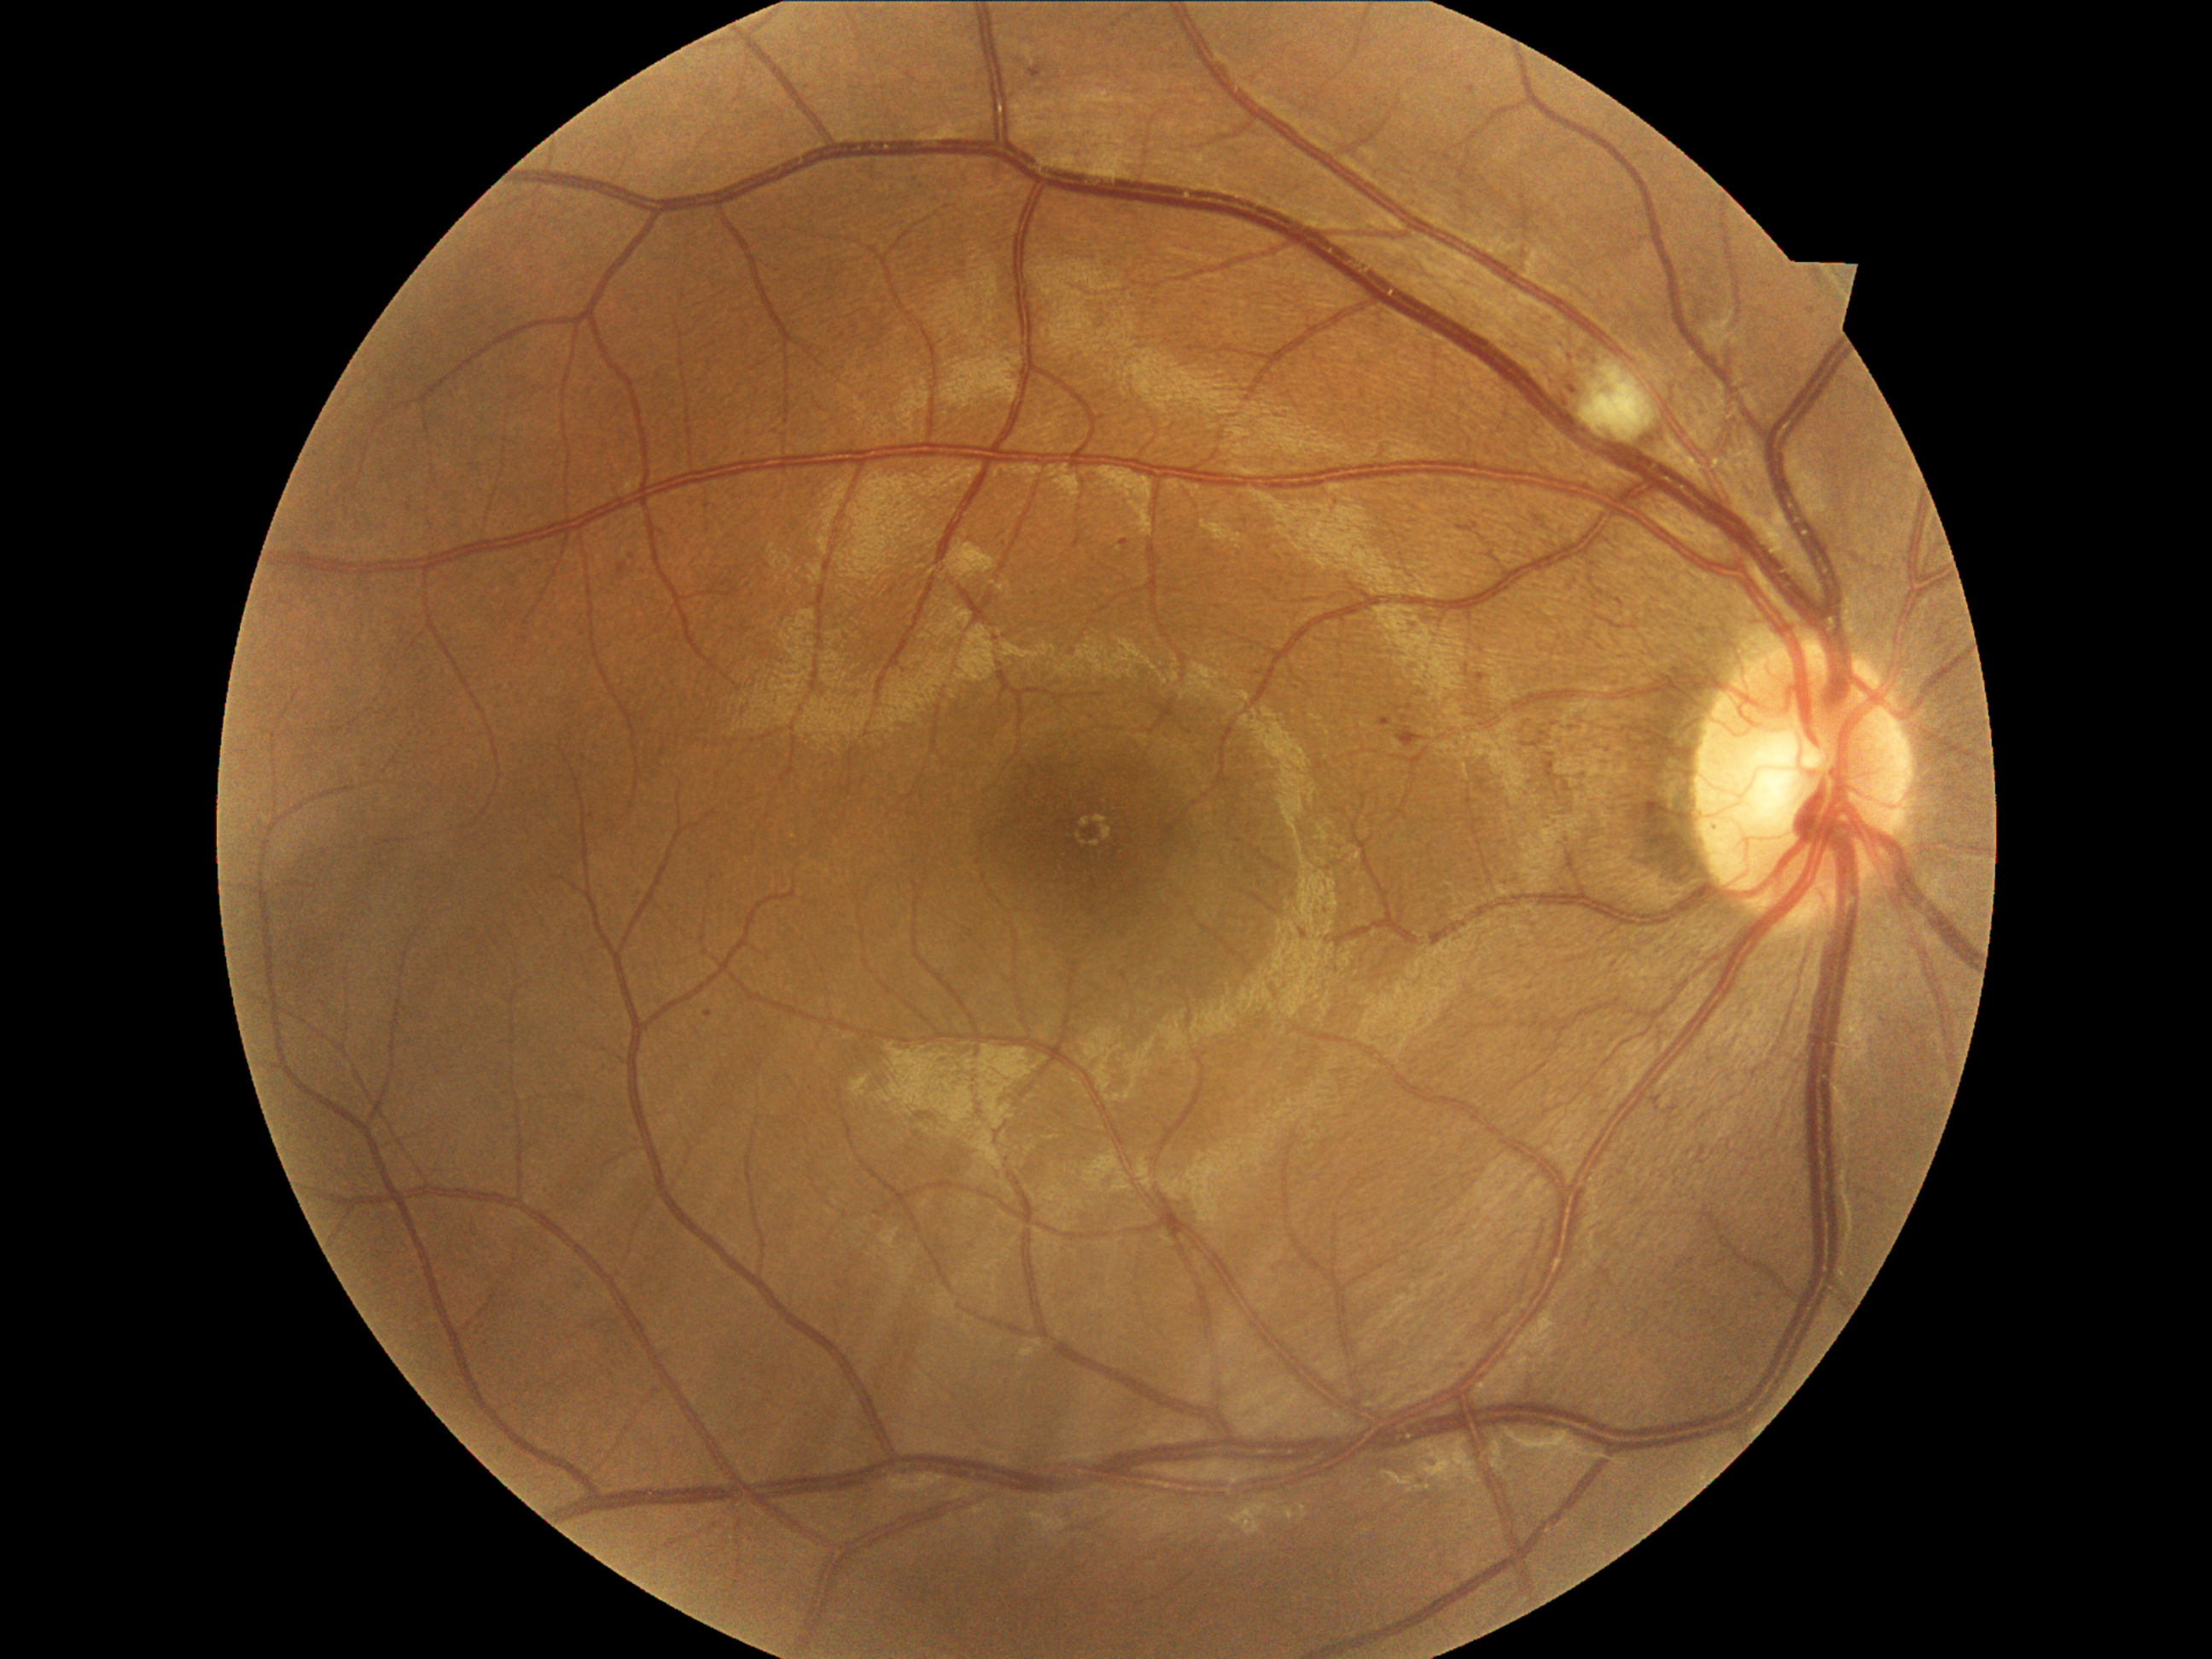 DR stage is grade 2 — more than just microaneurysms but less than severe NPDR.